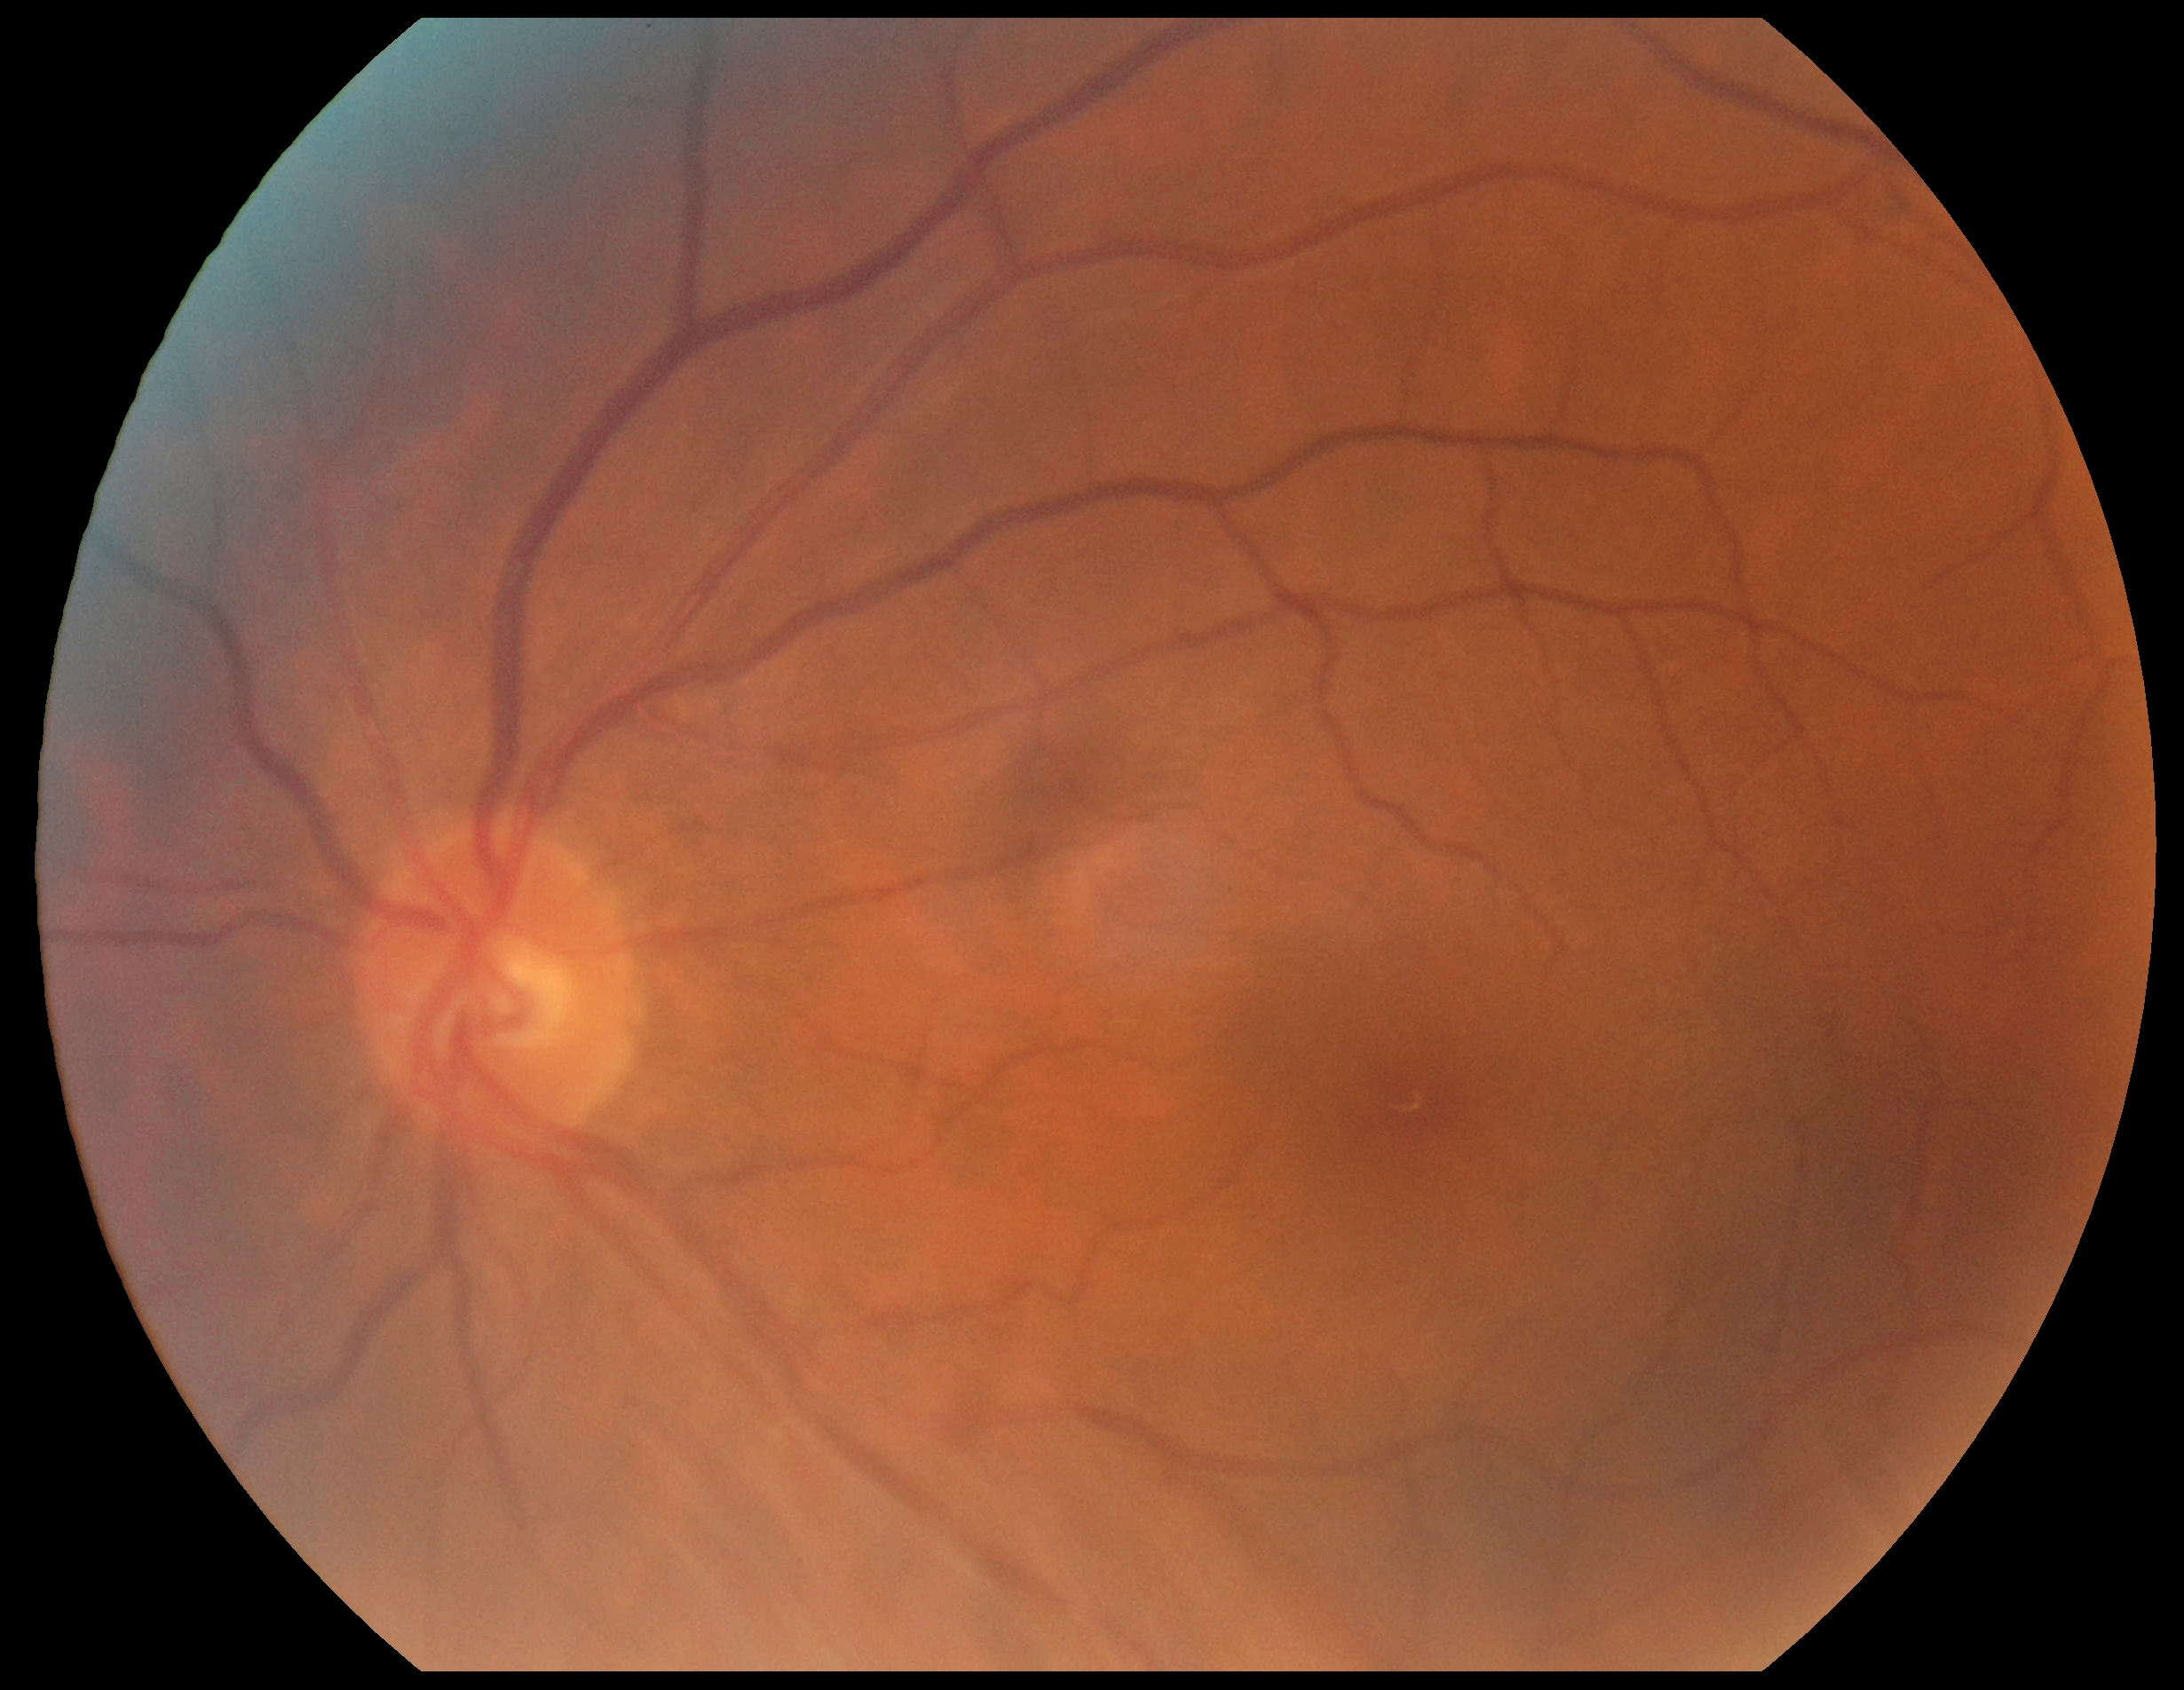
DR grade is no apparent diabetic retinopathy (0).